640x480px · RetCam wide-field infant fundus image — 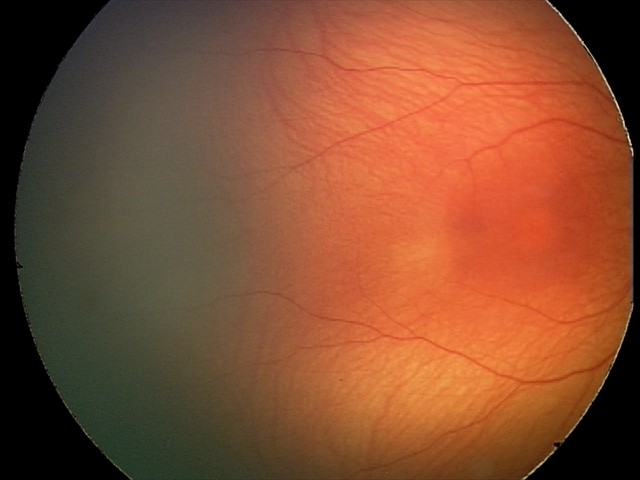

Screening diagnosis = normal.